Image size 848x848 · without pupil dilation — 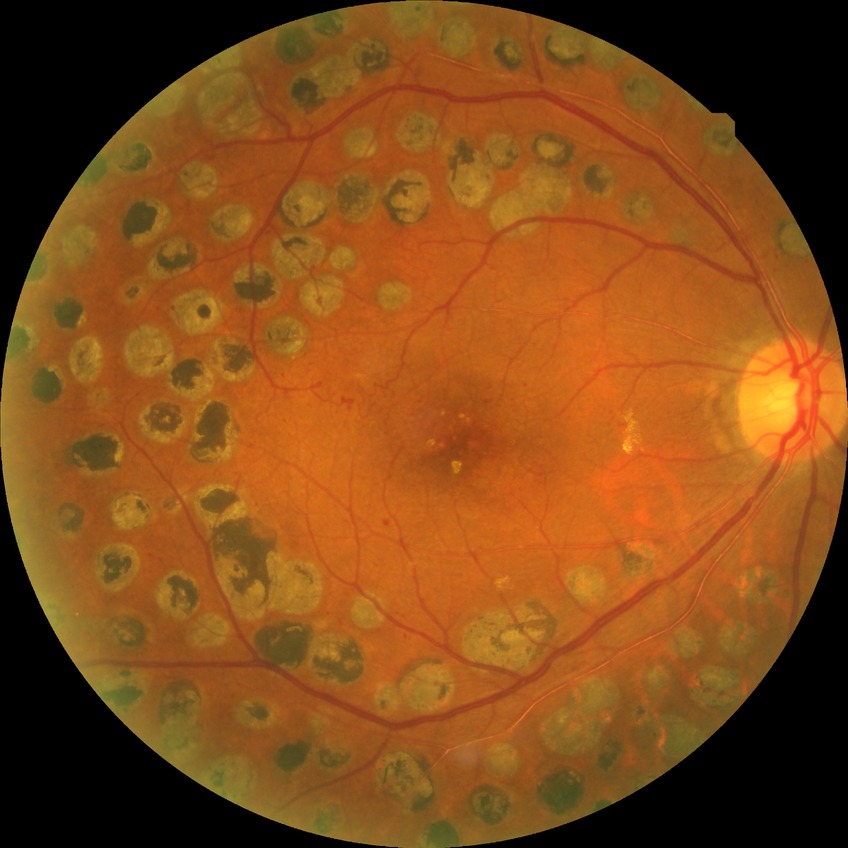 Modified Davis grading: proliferative diabetic retinopathy.